Forus 3Nethra Classic fundus camera:
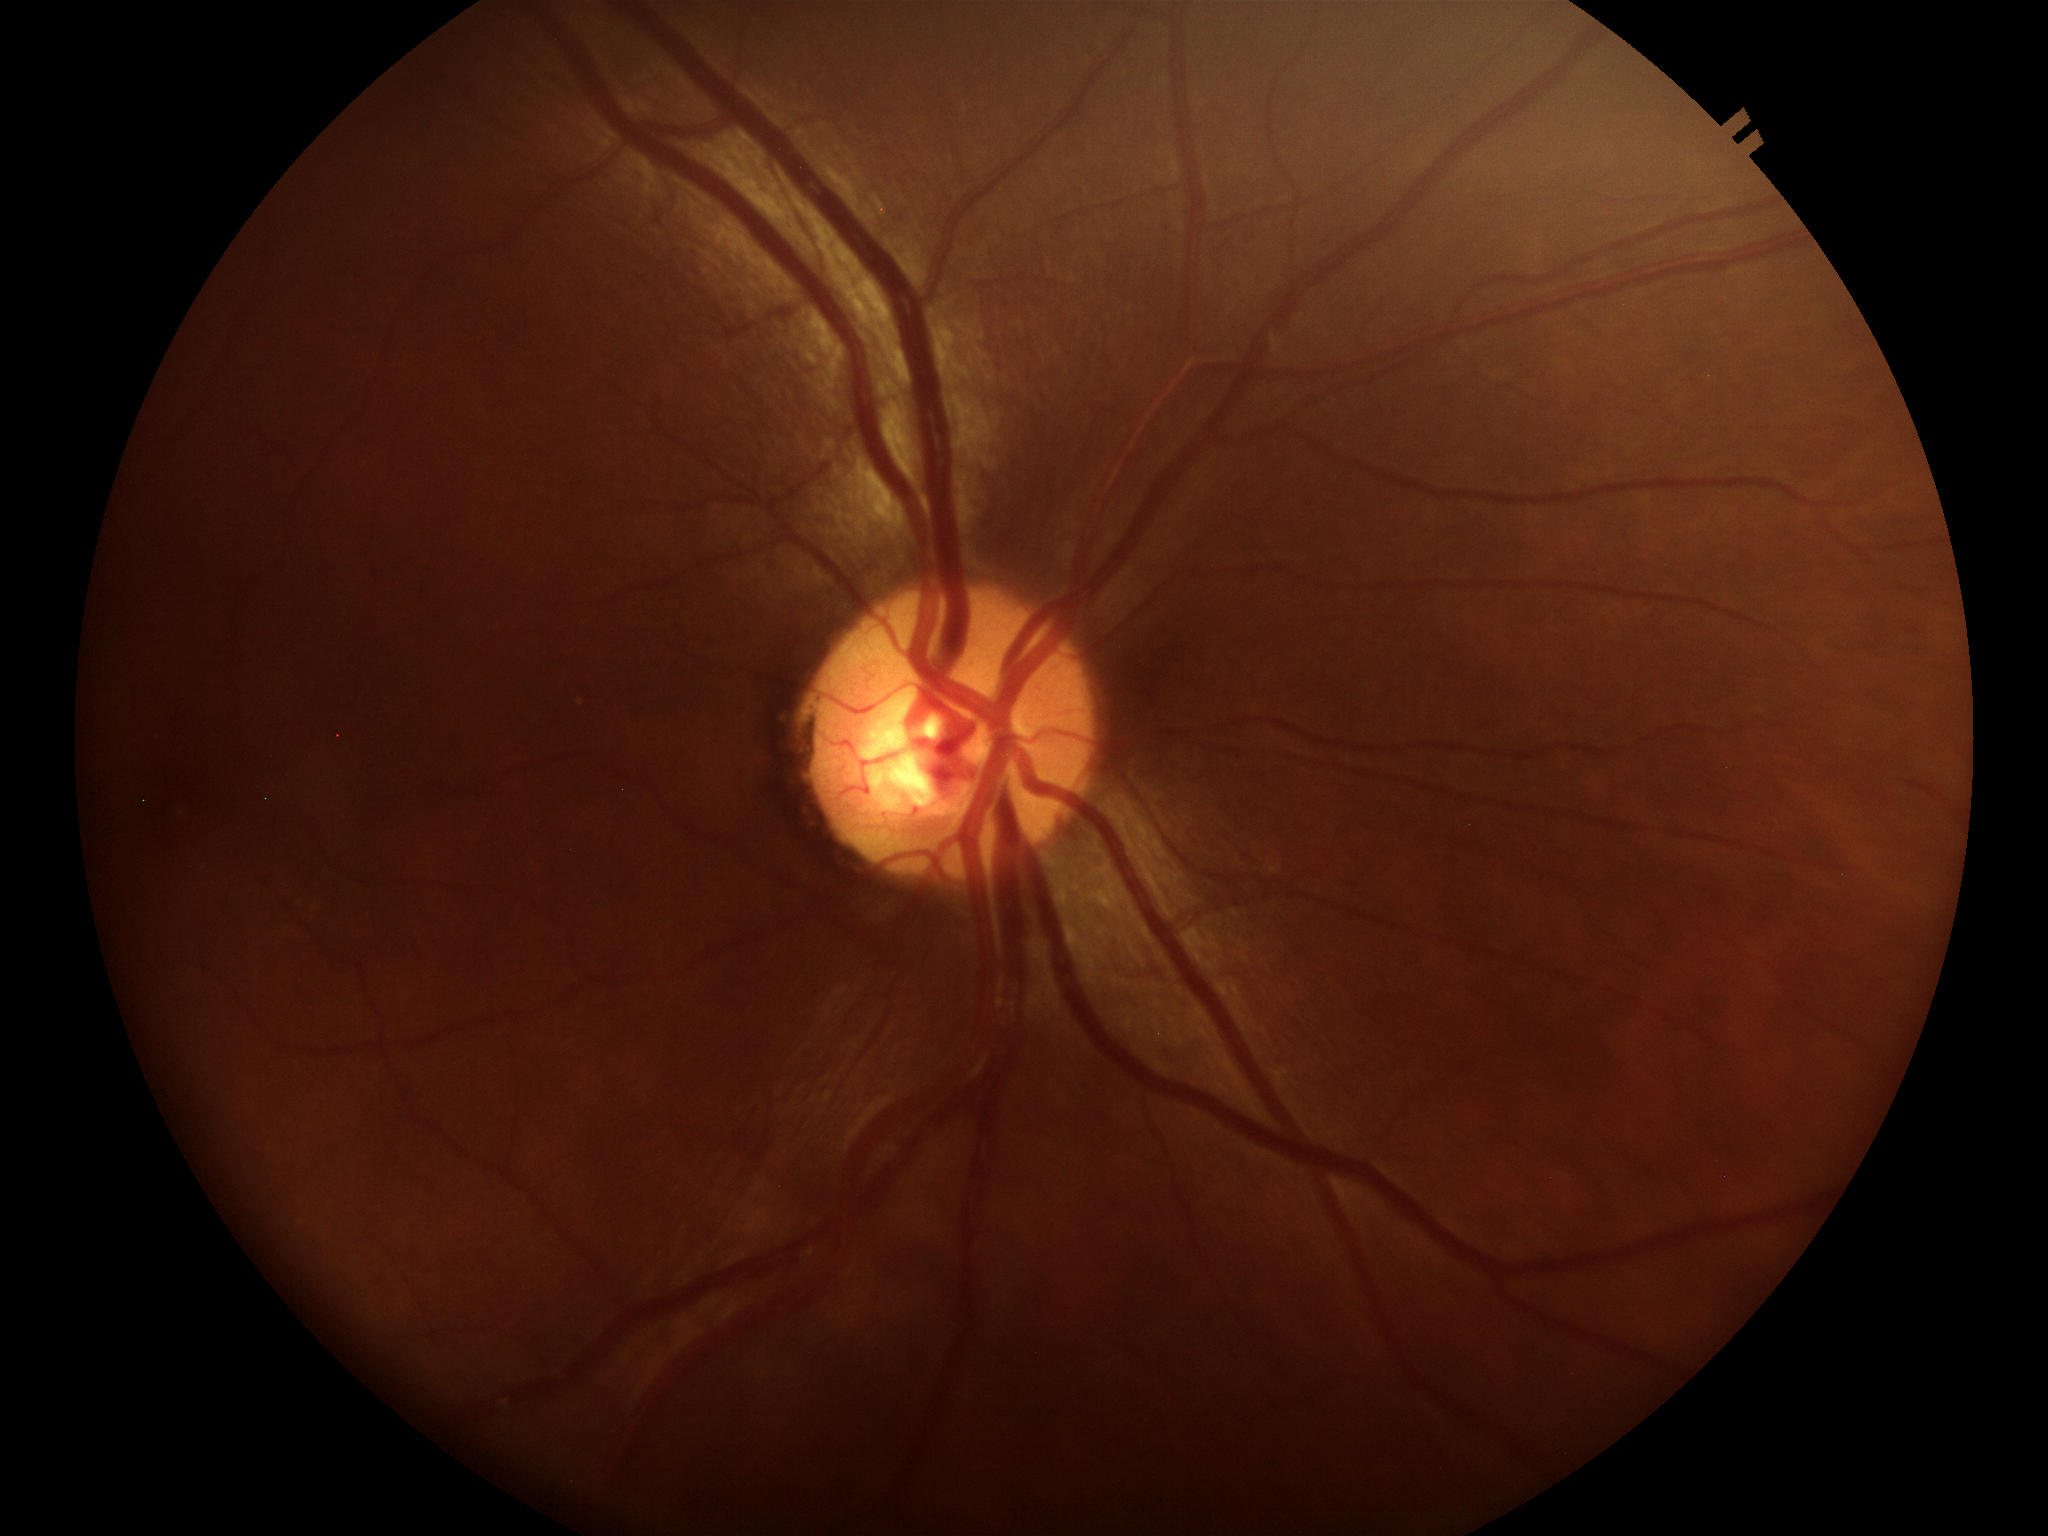
VCDR: 0.48 | HCDR: 0.51 | Glaucoma evaluation: no suspicious findings.